DR severity per modified Davis staging.
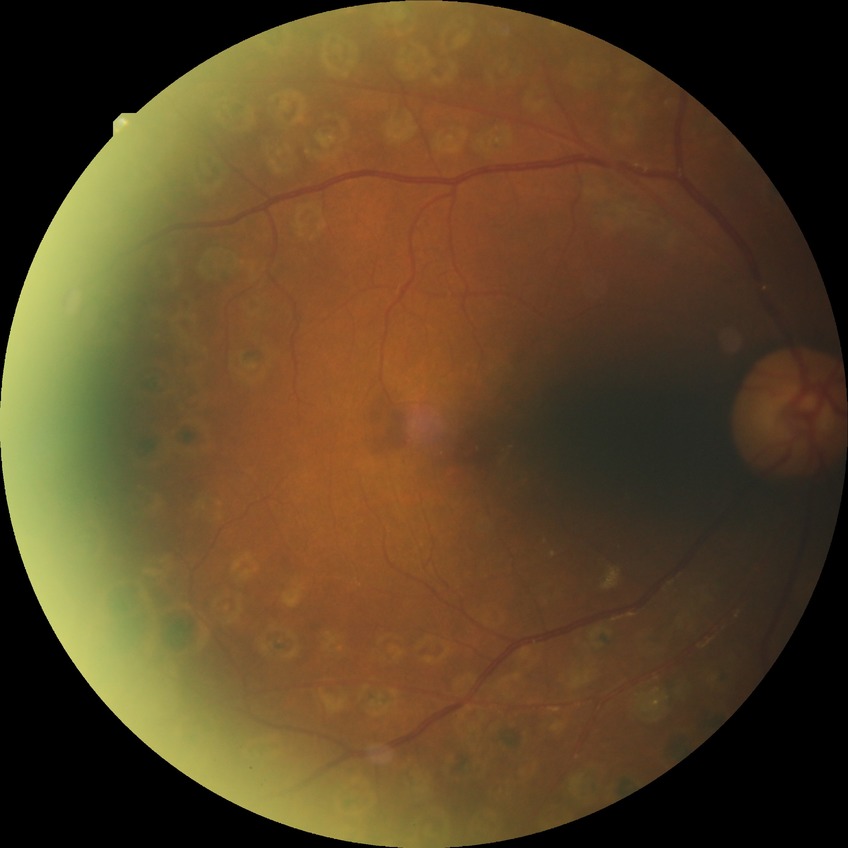

retinopathy stage = proliferative diabetic retinopathy.